Image size 2212x1659: 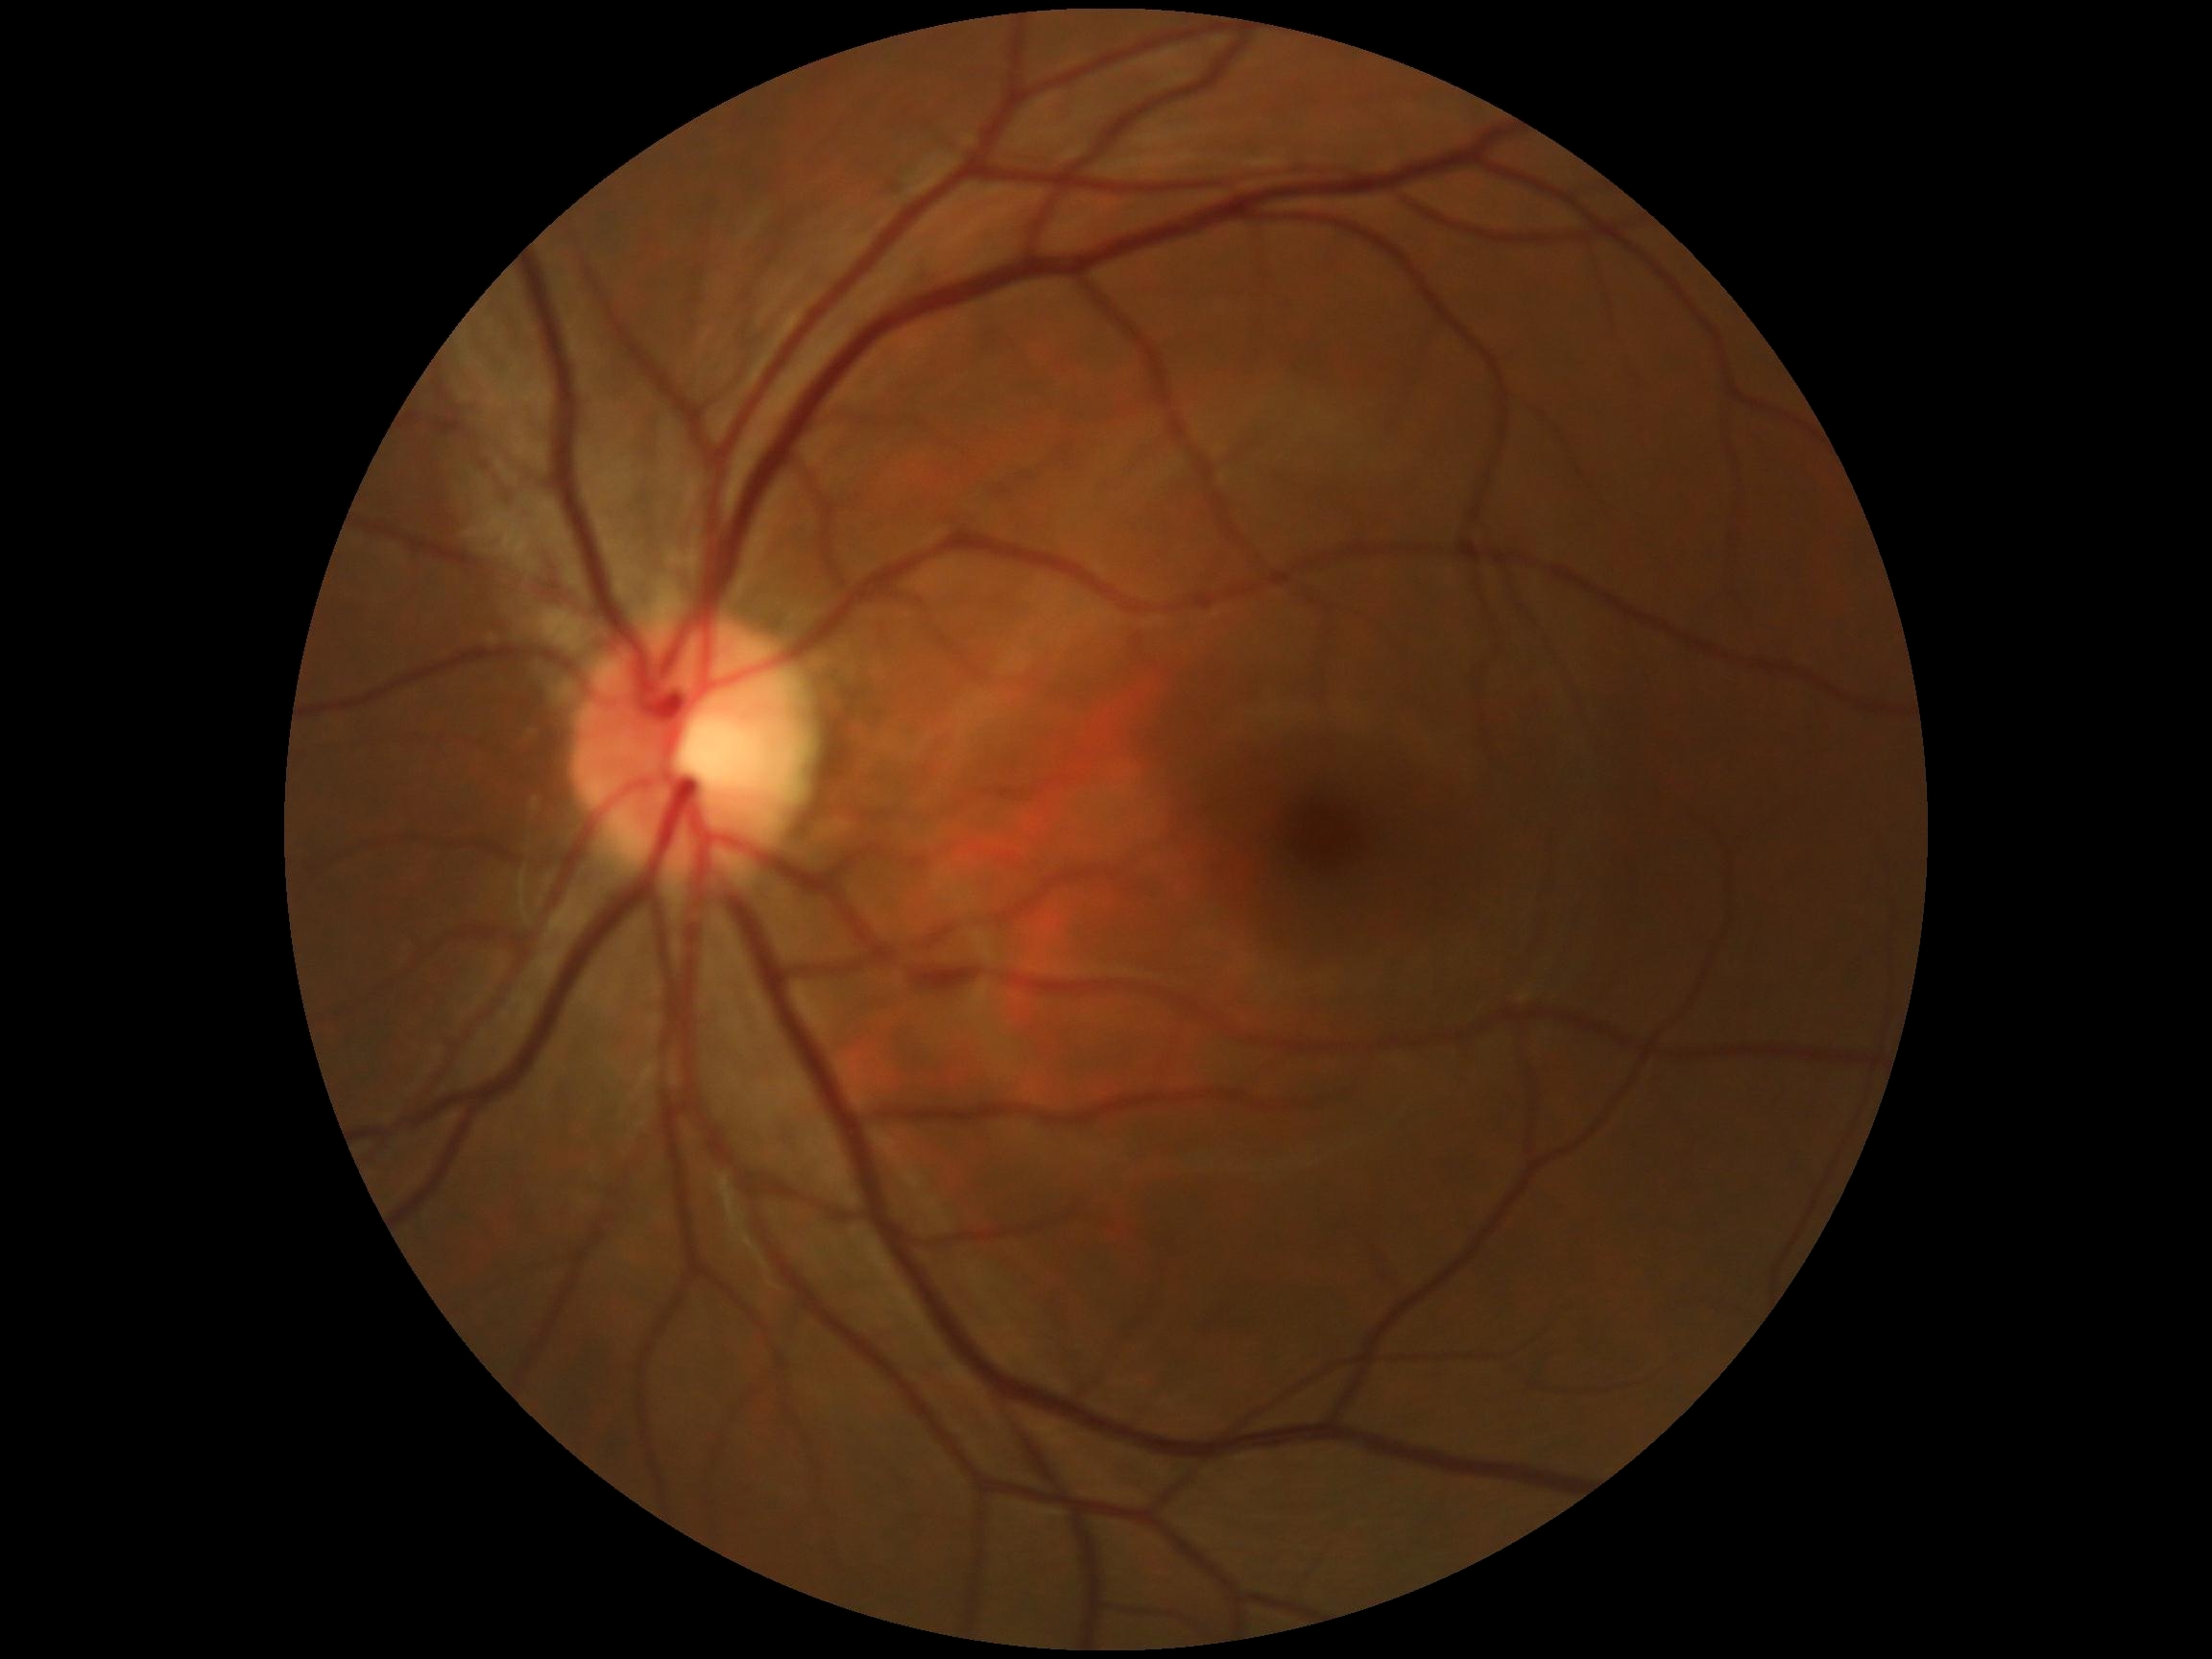 * DR severity: grade 0 (no apparent retinopathy) — no visible signs of diabetic retinopathy